Image size 1932x1932: 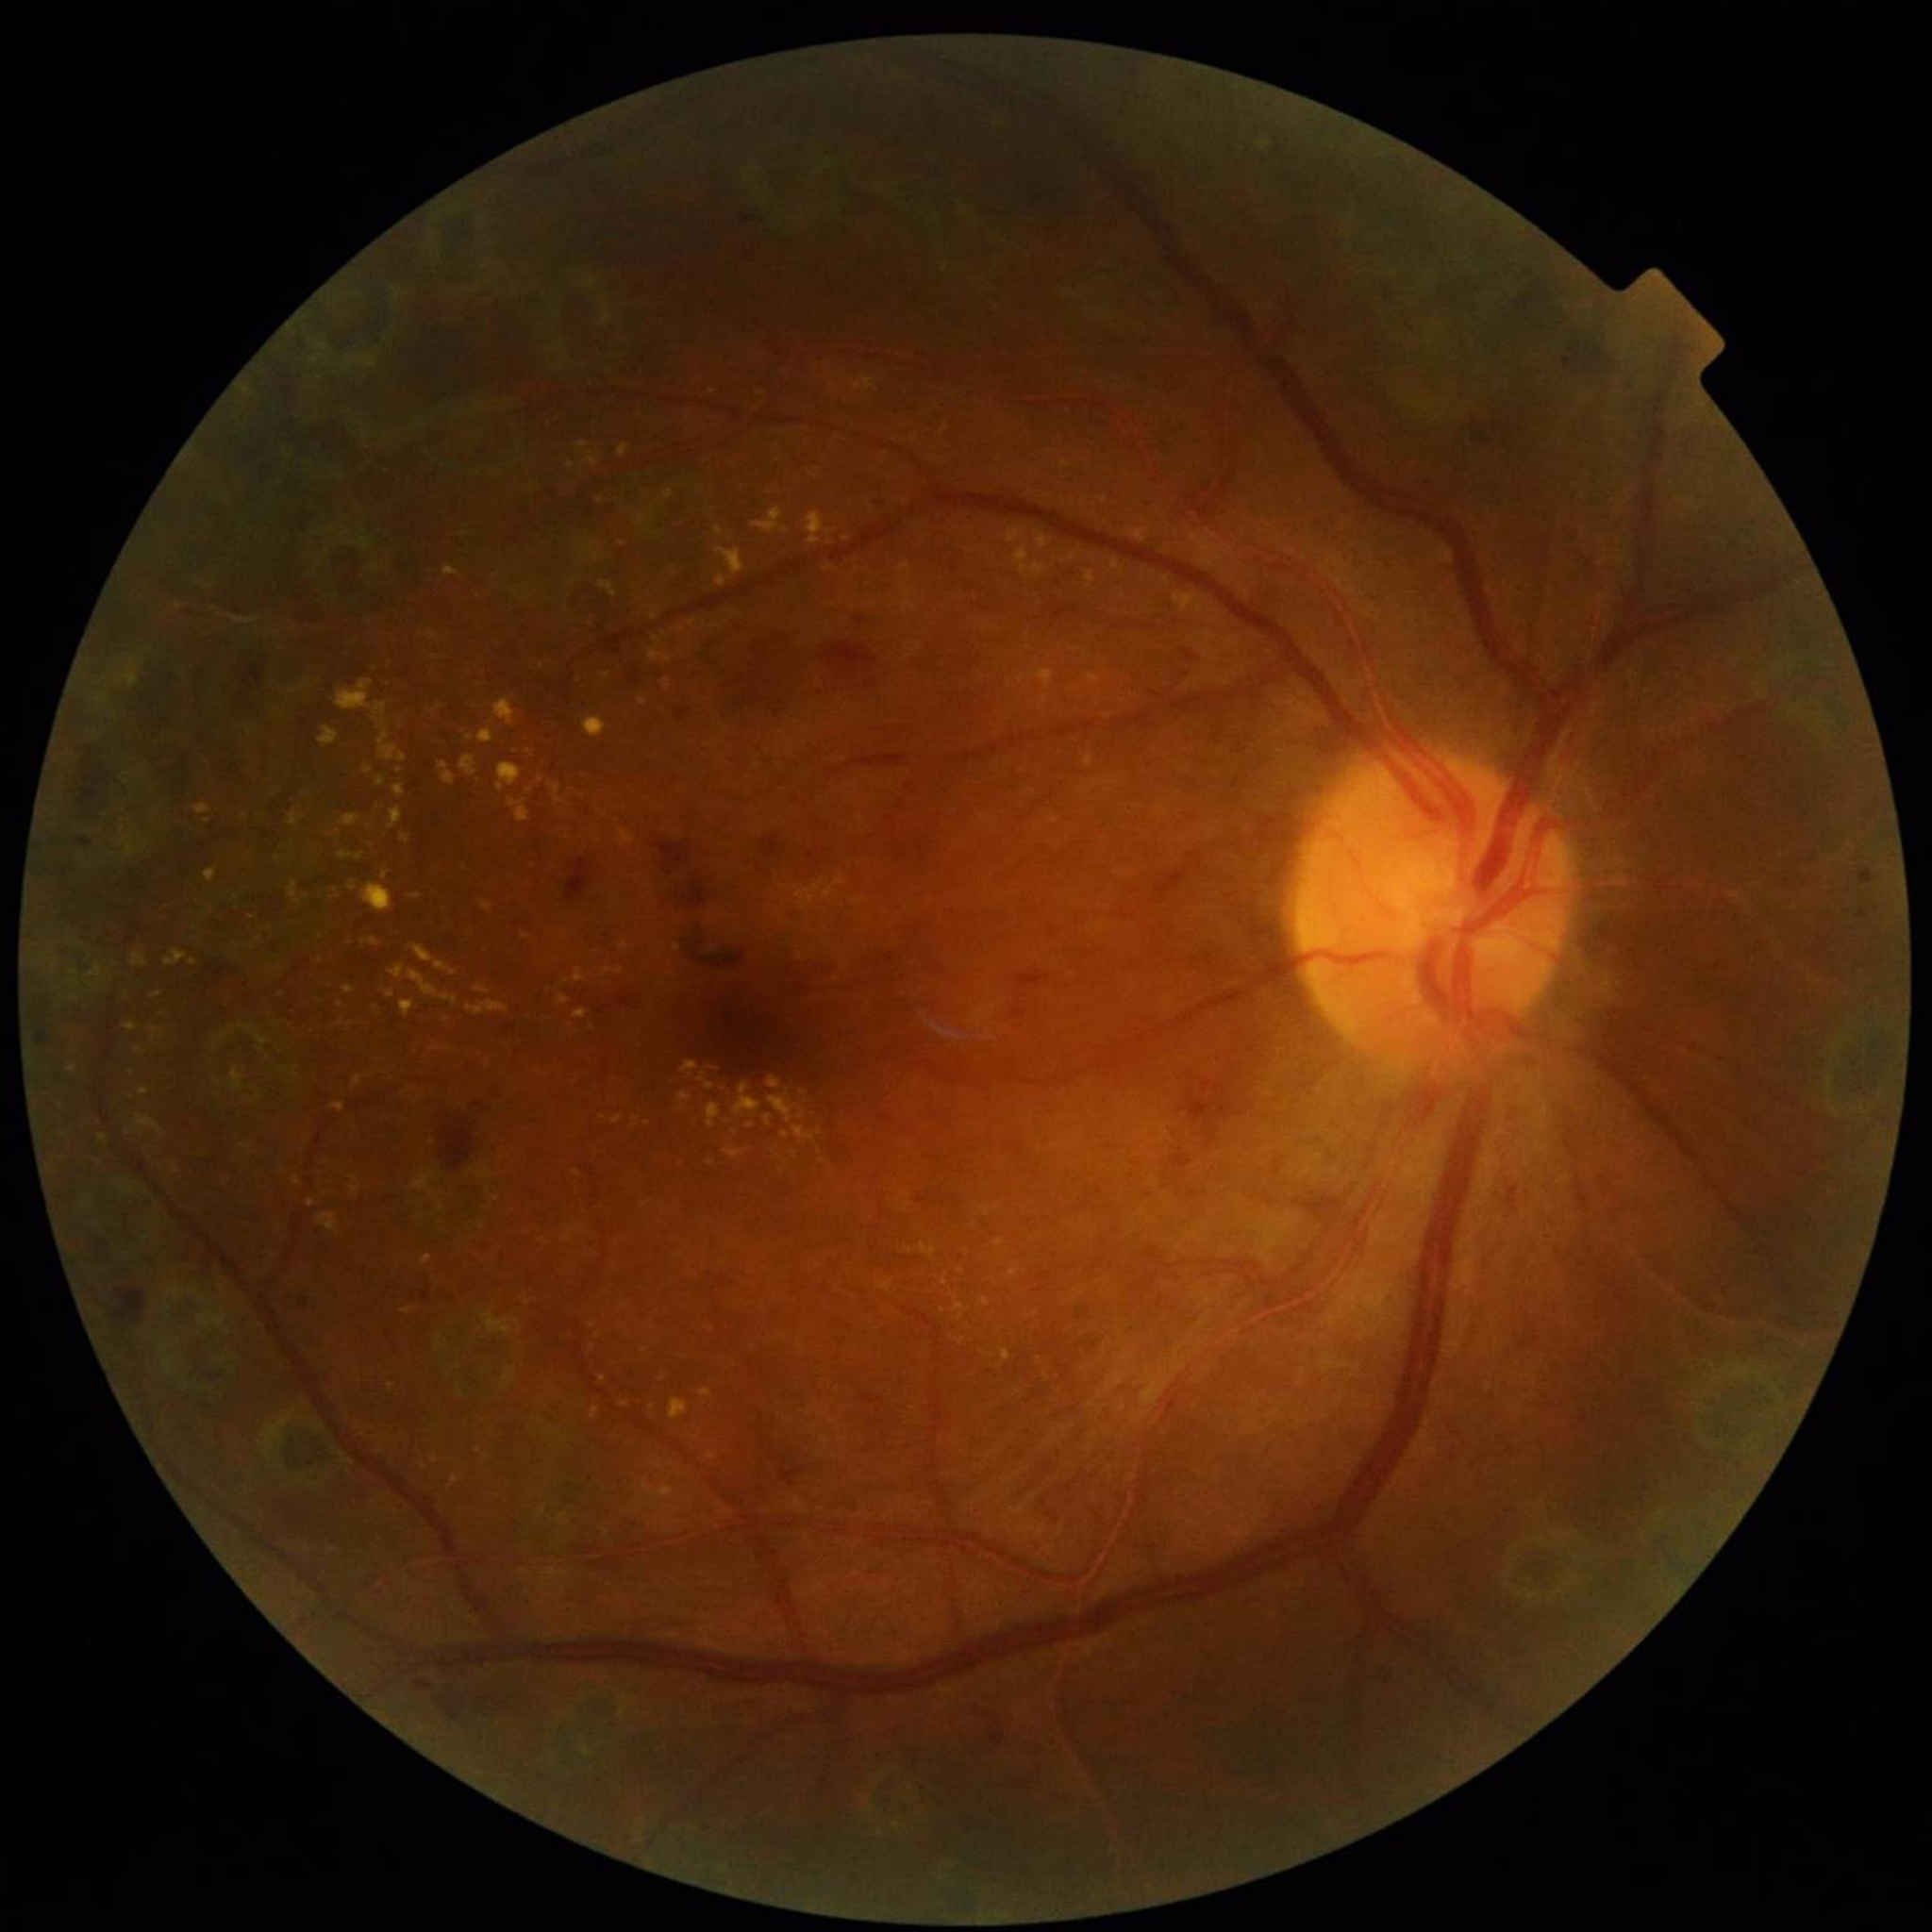 {
  "diagnosis": "DR"
}